2048 by 1536 pixels. FOV: 45 degrees:
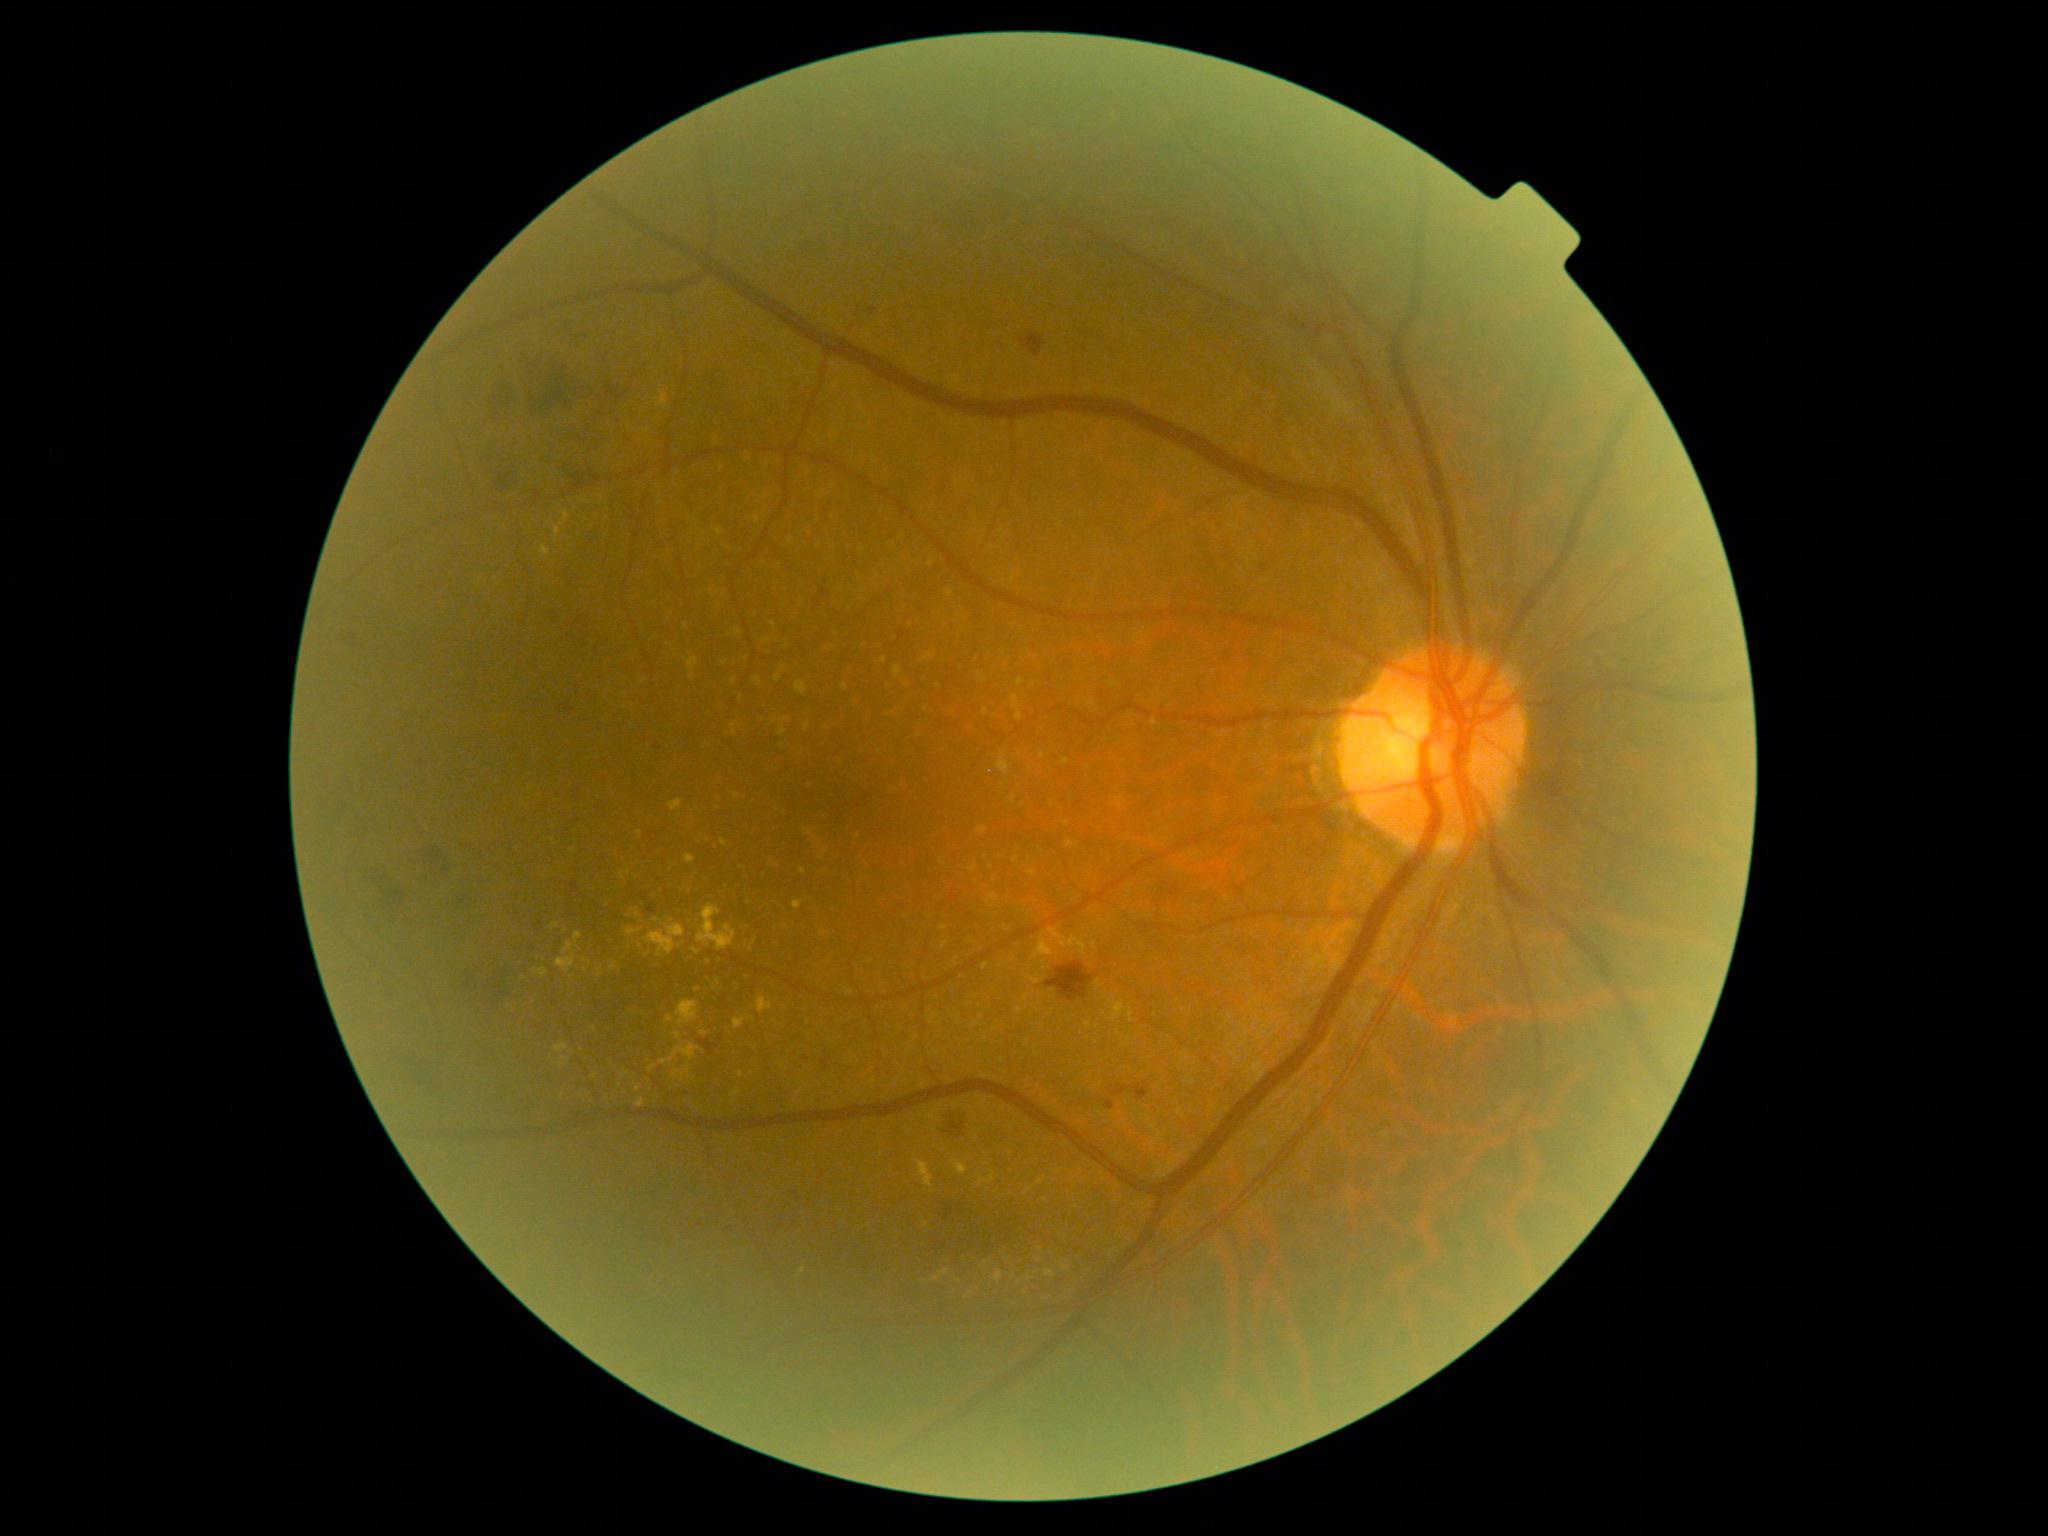 Diabetic retinopathy (DR) is moderate NPDR (grade 2) — more than just microaneurysms but less than severe NPDR. Hard exudates (EXs) (partial list) at bbox=(660, 1043, 700, 1066) | bbox=(1045, 1270, 1056, 1277) | bbox=(681, 1073, 685, 1081) | bbox=(540, 545, 550, 556) | bbox=(670, 799, 683, 812) | bbox=(635, 1099, 645, 1108) | bbox=(953, 1159, 968, 1175) | bbox=(1062, 1264, 1070, 1271) | bbox=(994, 1270, 1004, 1283) | bbox=(611, 963, 618, 971). Small EXs near [x=573, y=976] | [x=736, y=1092] | [x=1040, y=1260] | [x=803, y=1270] | [x=679, y=946] | [x=563, y=1095] | [x=1103, y=1174].